Acquired with a NIDEK AFC-230, color fundus image, 848 by 848 pixels, nonmydriatic, FOV: 45 degrees — 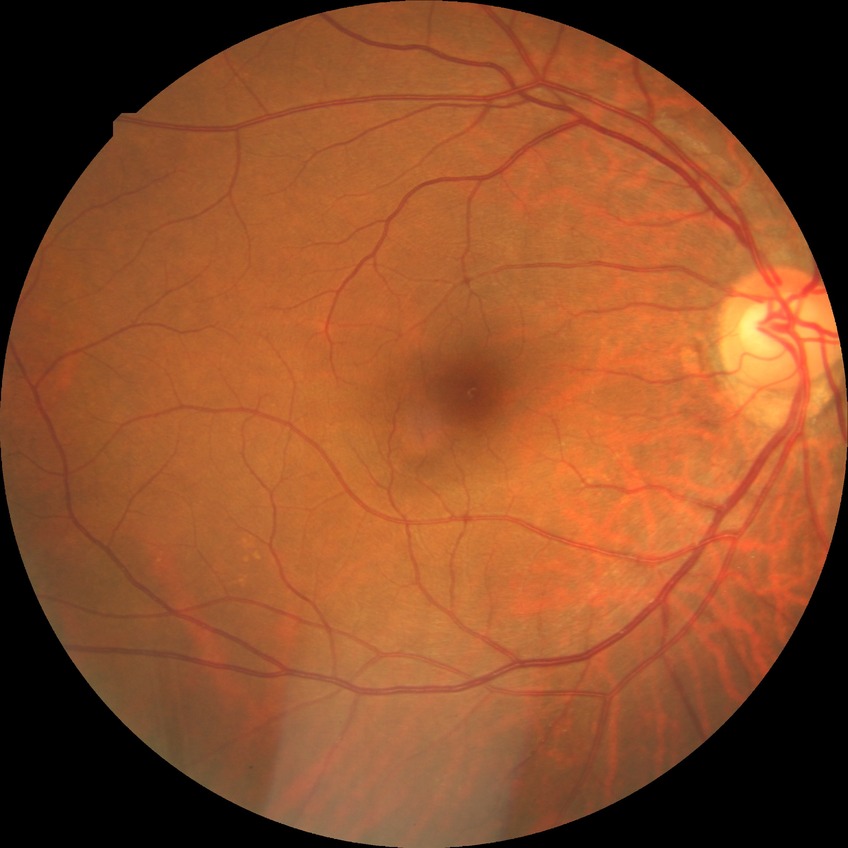 Diabetic retinopathy (DR) is NDR (no diabetic retinopathy).